Captured on a Forus 3Nethra Classic
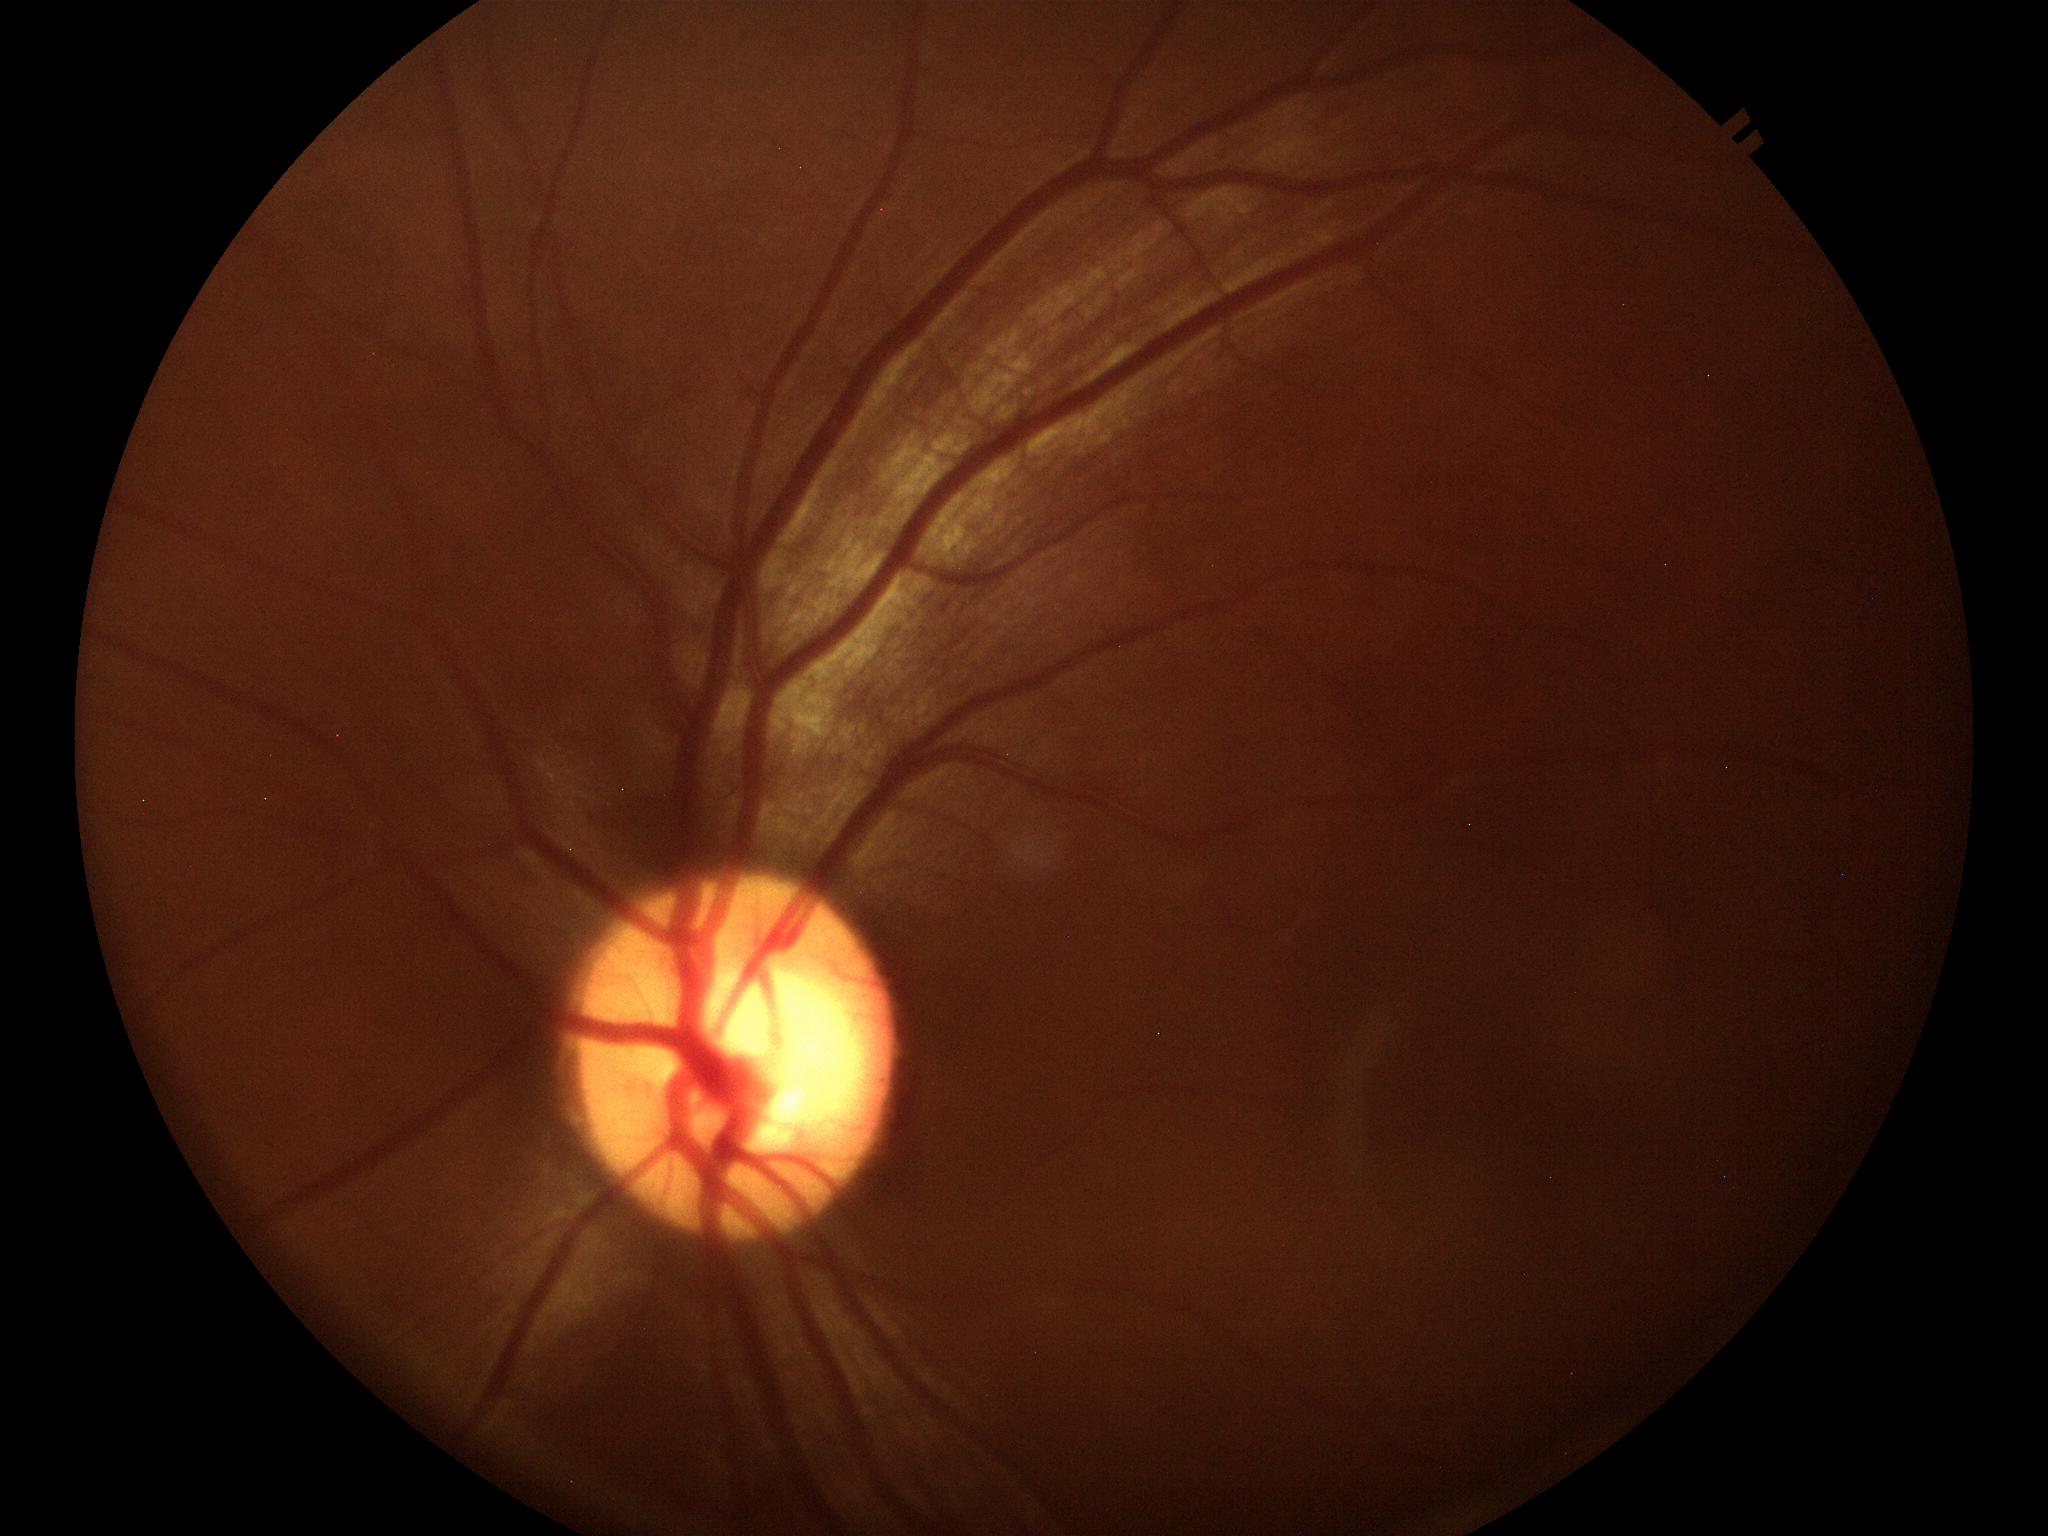 Glaucoma screening impression: suspicious (3 of 5 graders flagged glaucoma suspect) | vertical CDR: 0.60.